CFP, DR severity per modified Davis staging, 848x848, 45-degree field of view
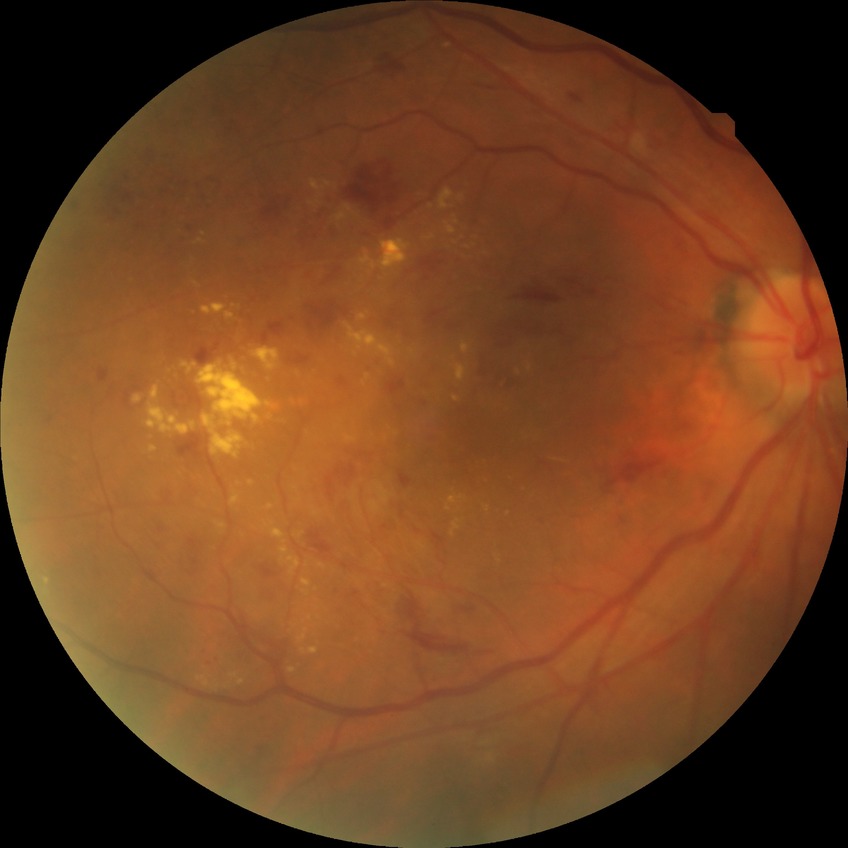

Annotations:
– diabetic retinopathy severity: simple diabetic retinopathy